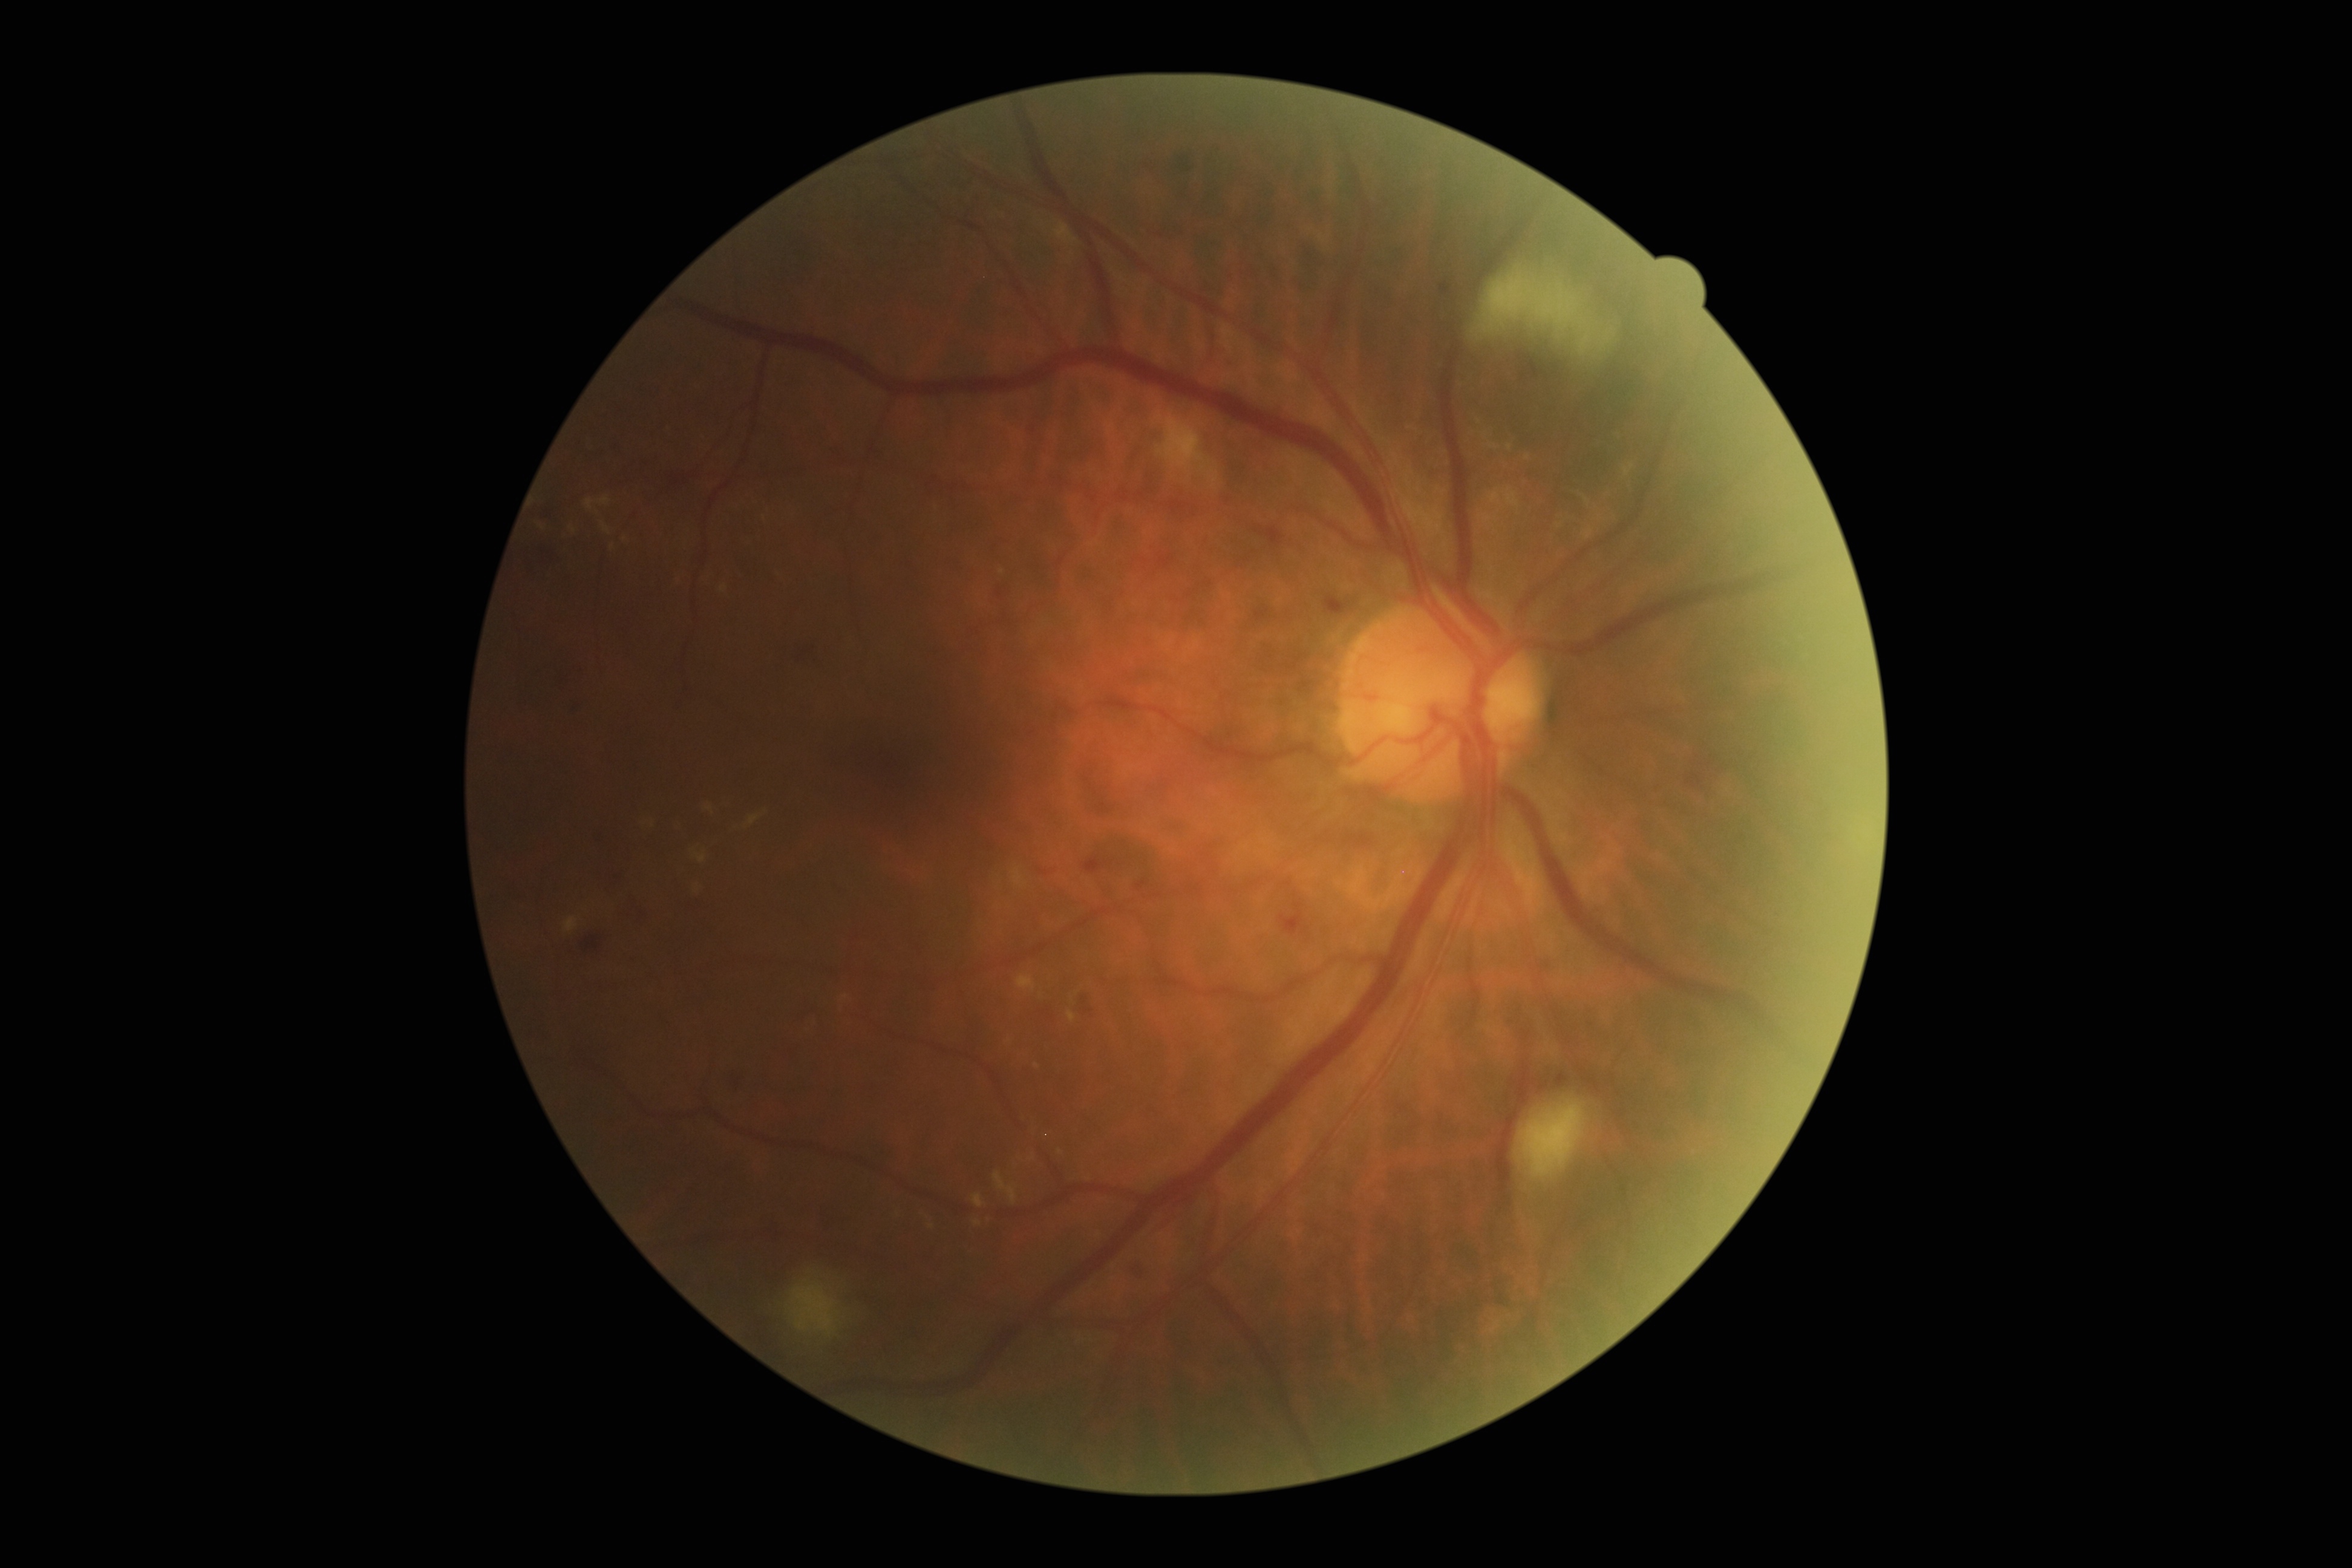
Retinopathy: grade 2 (moderate NPDR).